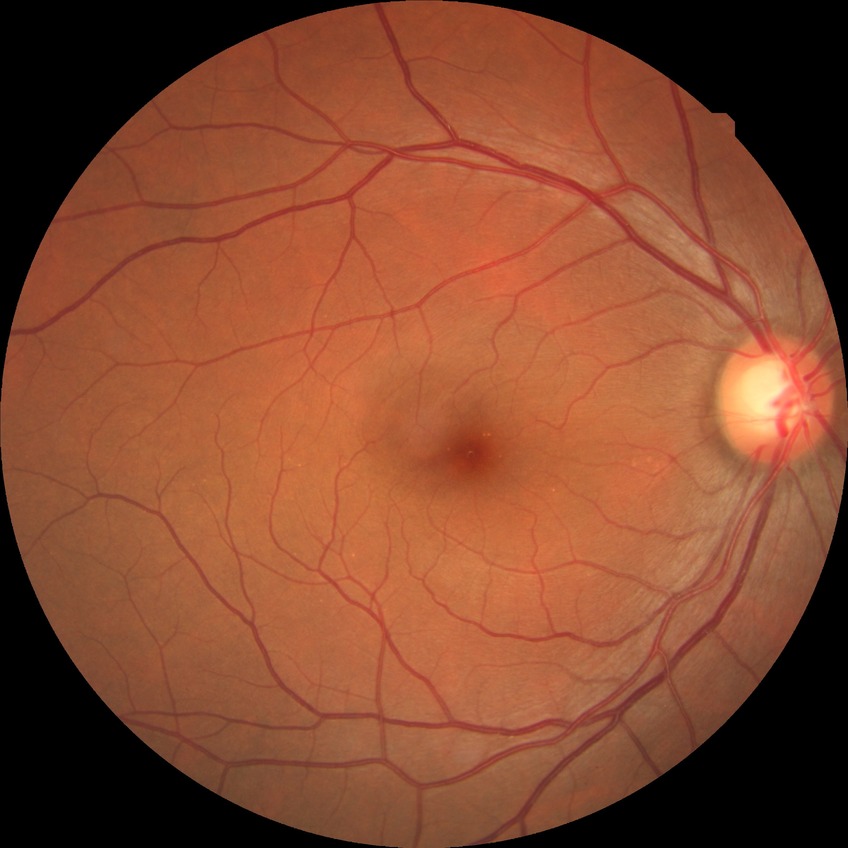
Retinopathy grade: no diabetic retinopathy.